Color fundus photograph — 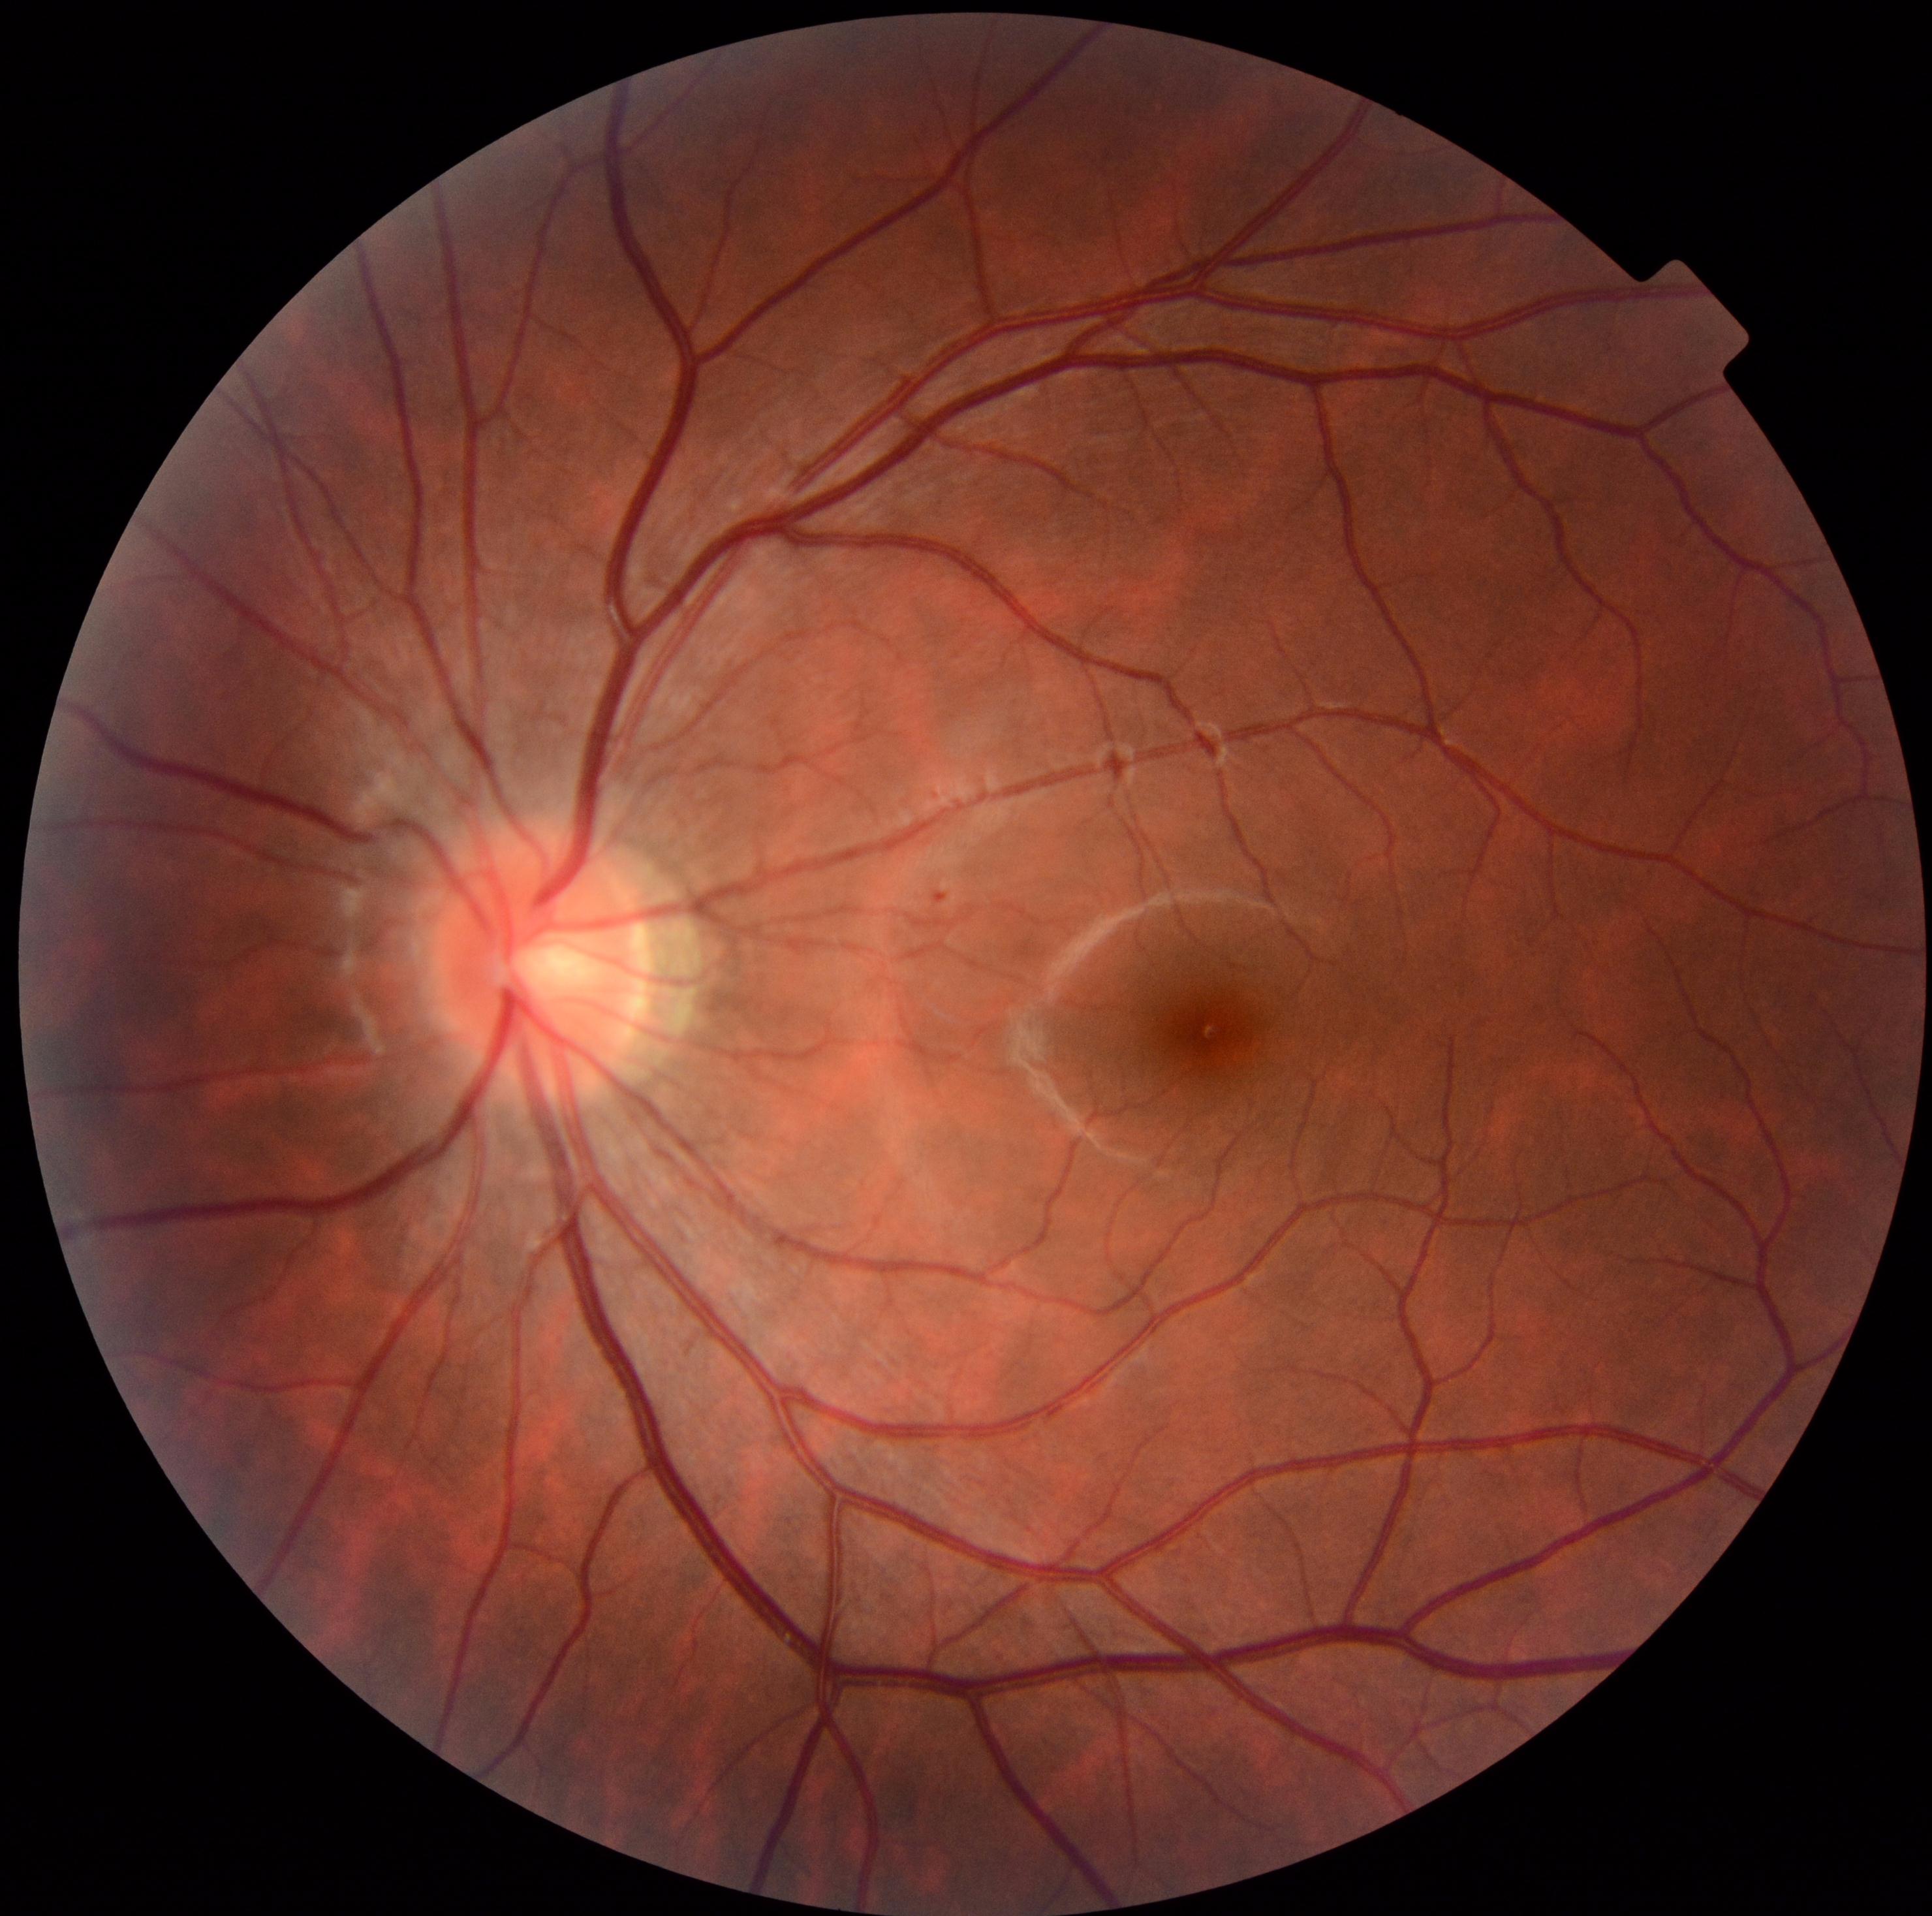

Diabetic retinopathy (DR): grade 1; non-proliferative diabetic retinopathy. No soft exudates (SEs) identified. No hard exudates (EXs) identified. No hemorrhages (HEs) identified. Microaneurysms (MAs) at box(935, 893, 947, 905).